Diabetic retinopathy graded by the modified Davis classification · posterior pole photograph:
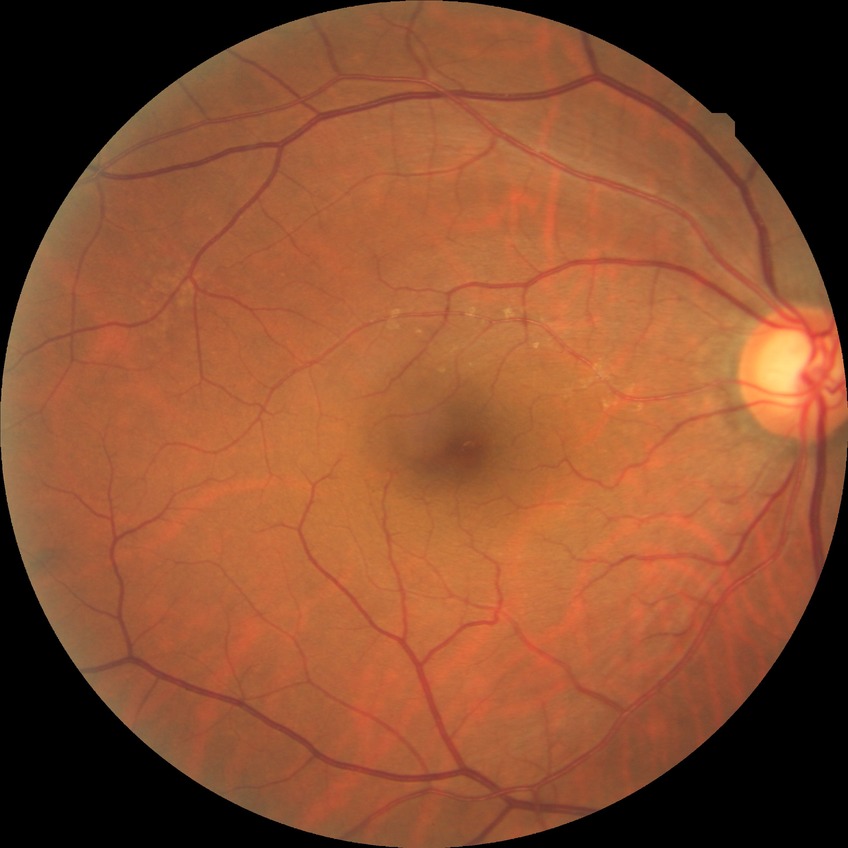 diabetic retinopathy (DR) = no diabetic retinopathy (NDR).